FOV: 45 degrees — 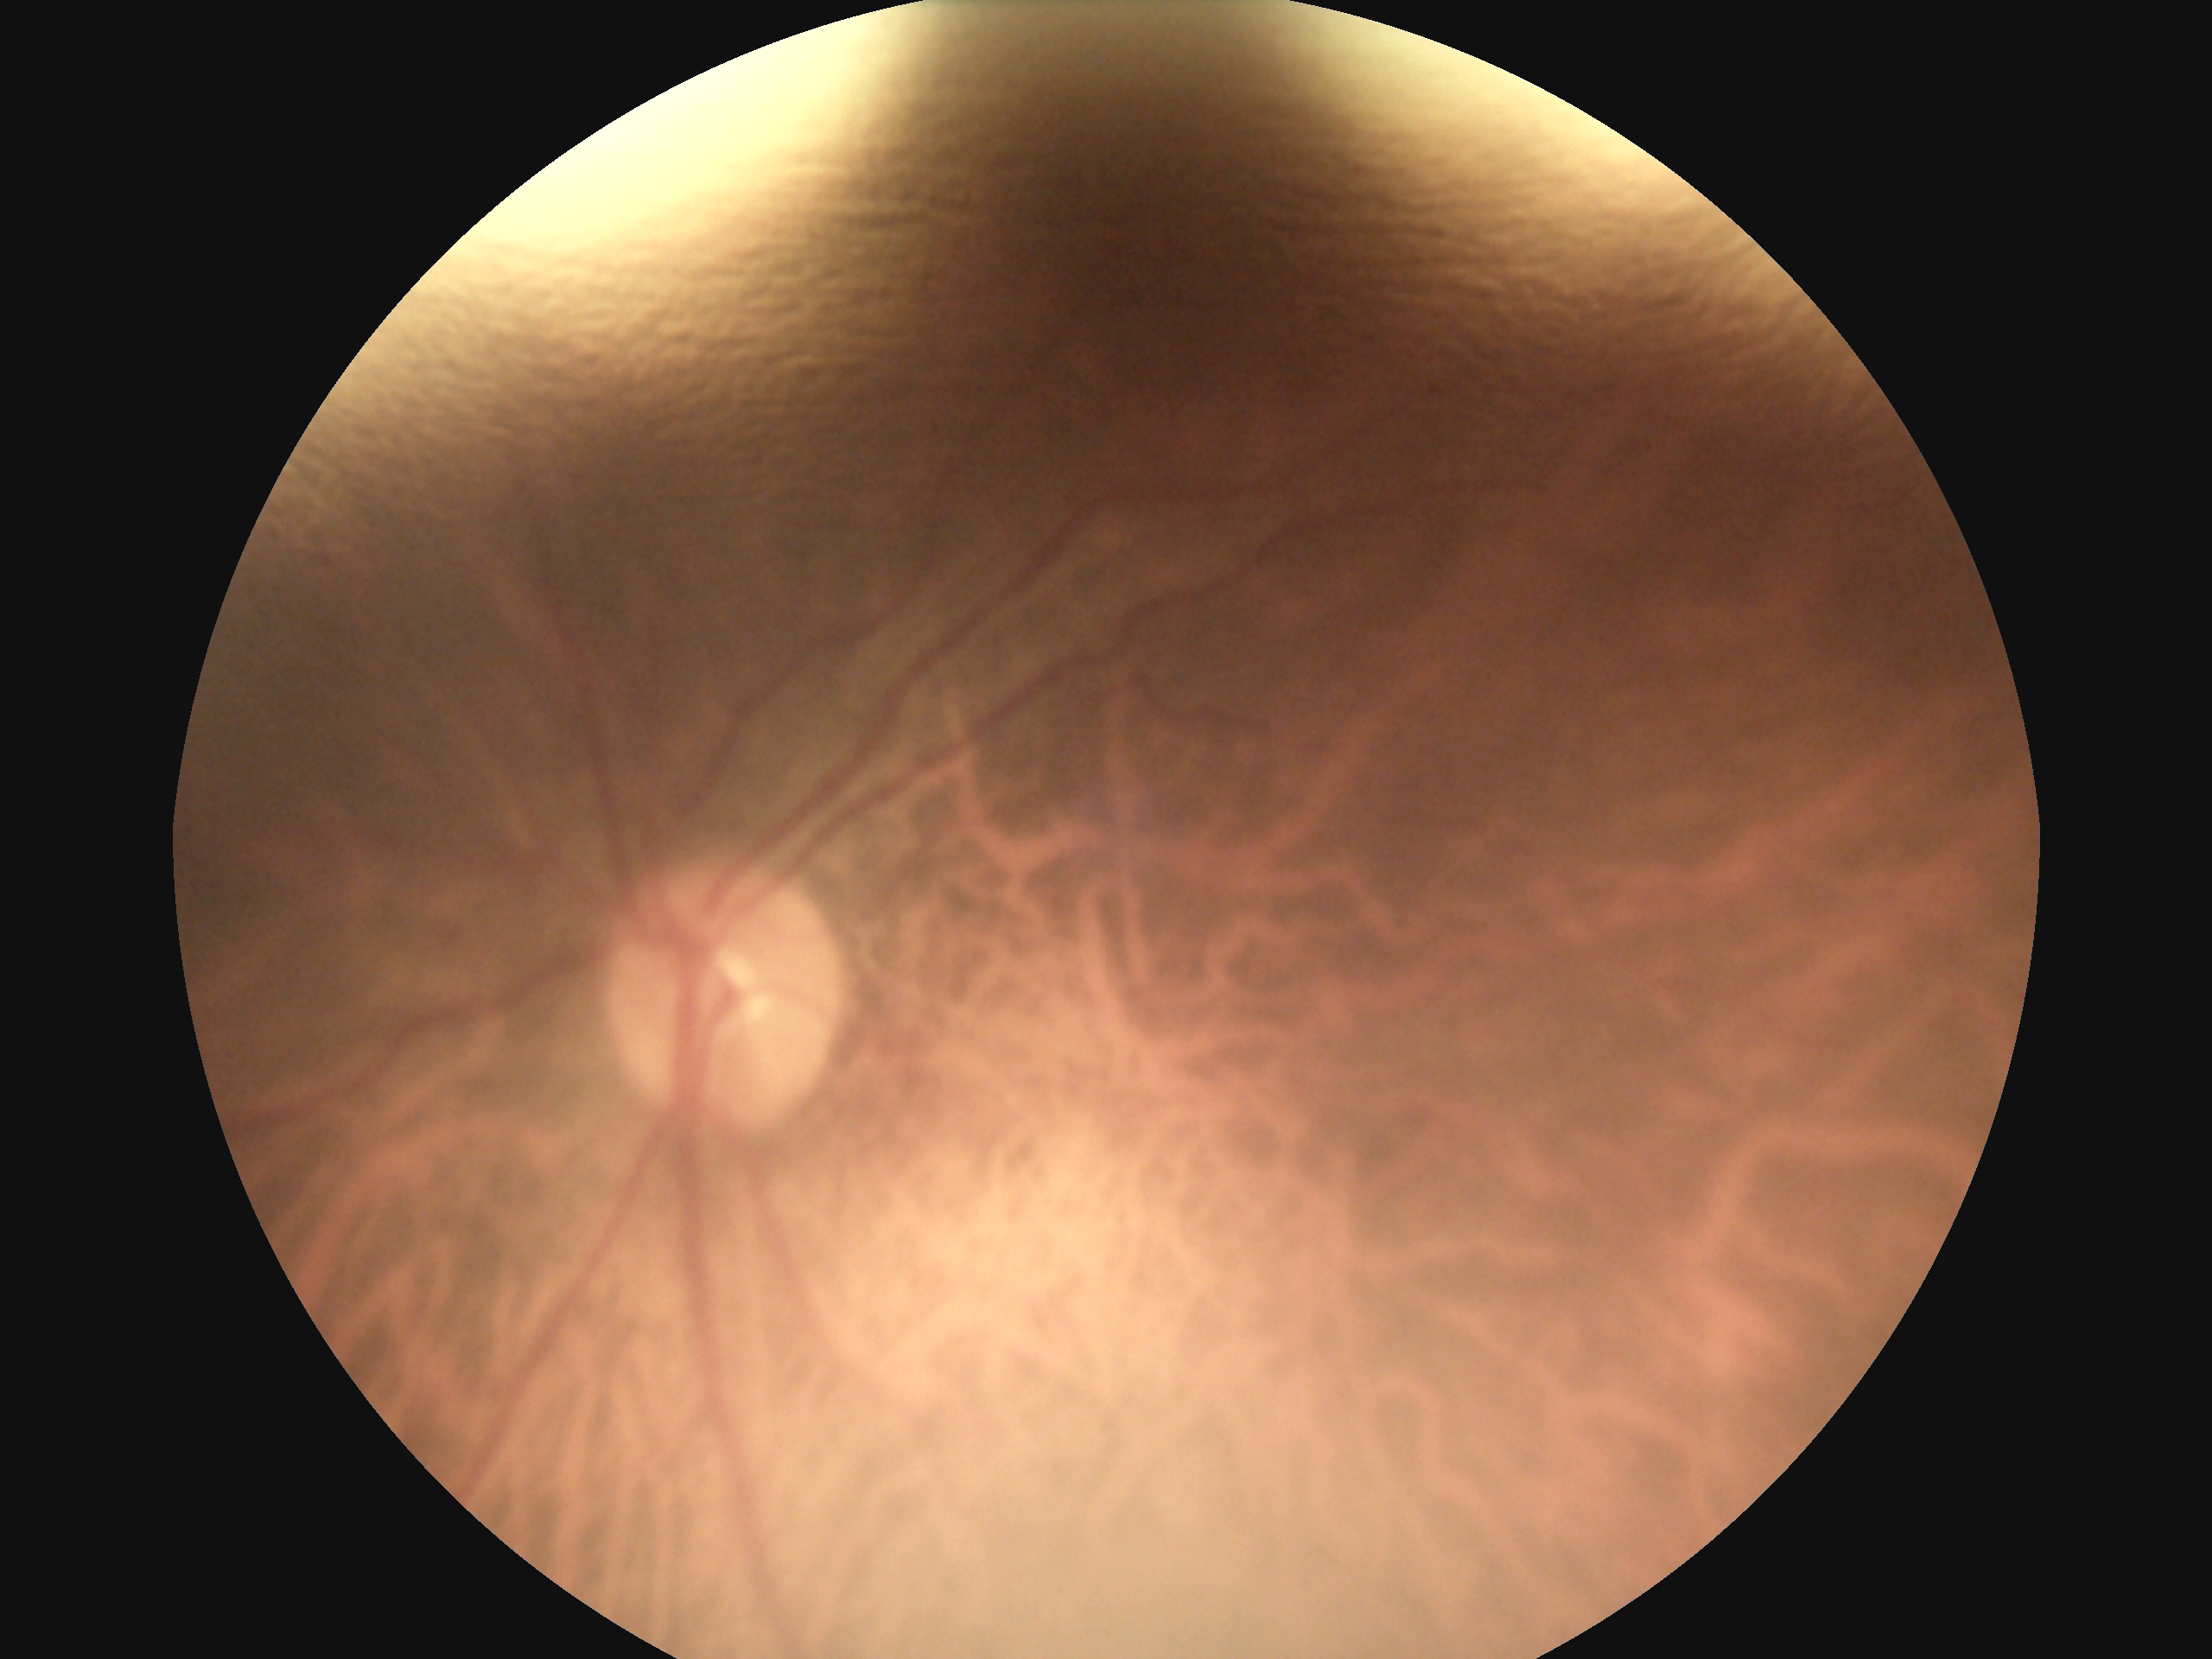
diabetic retinopathy grade=0 — no visible signs of diabetic retinopathy; DR impression=no signs of DR.